CFP — 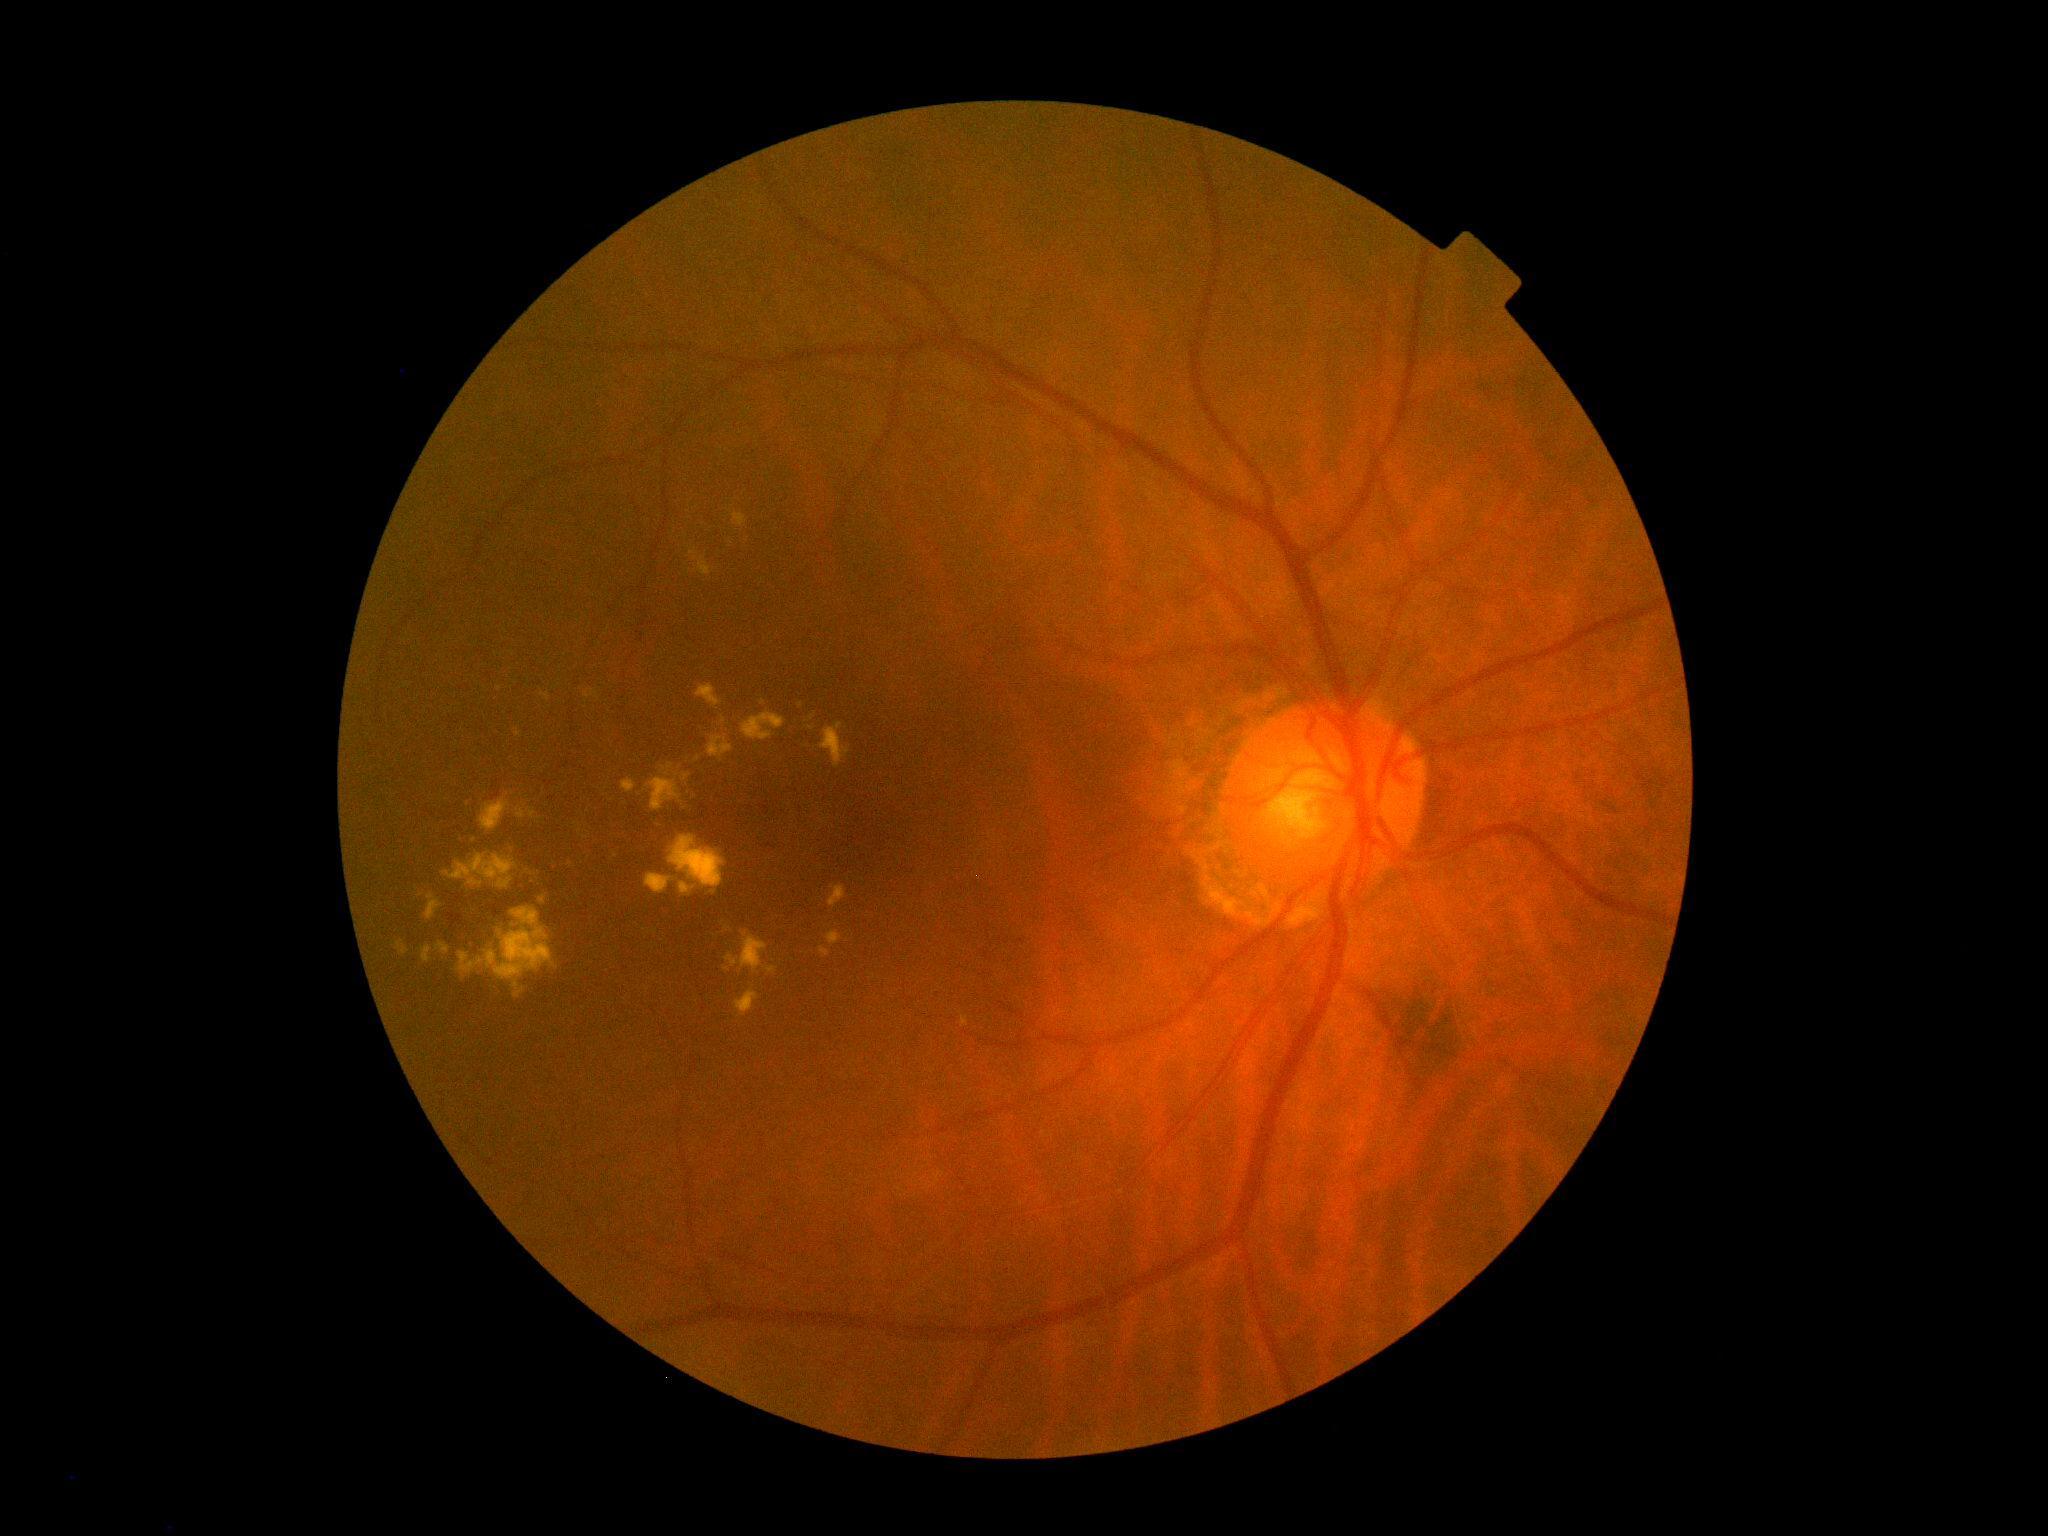

DR class=non-proliferative diabetic retinopathy; DR severity=moderate NPDR (grade 2).